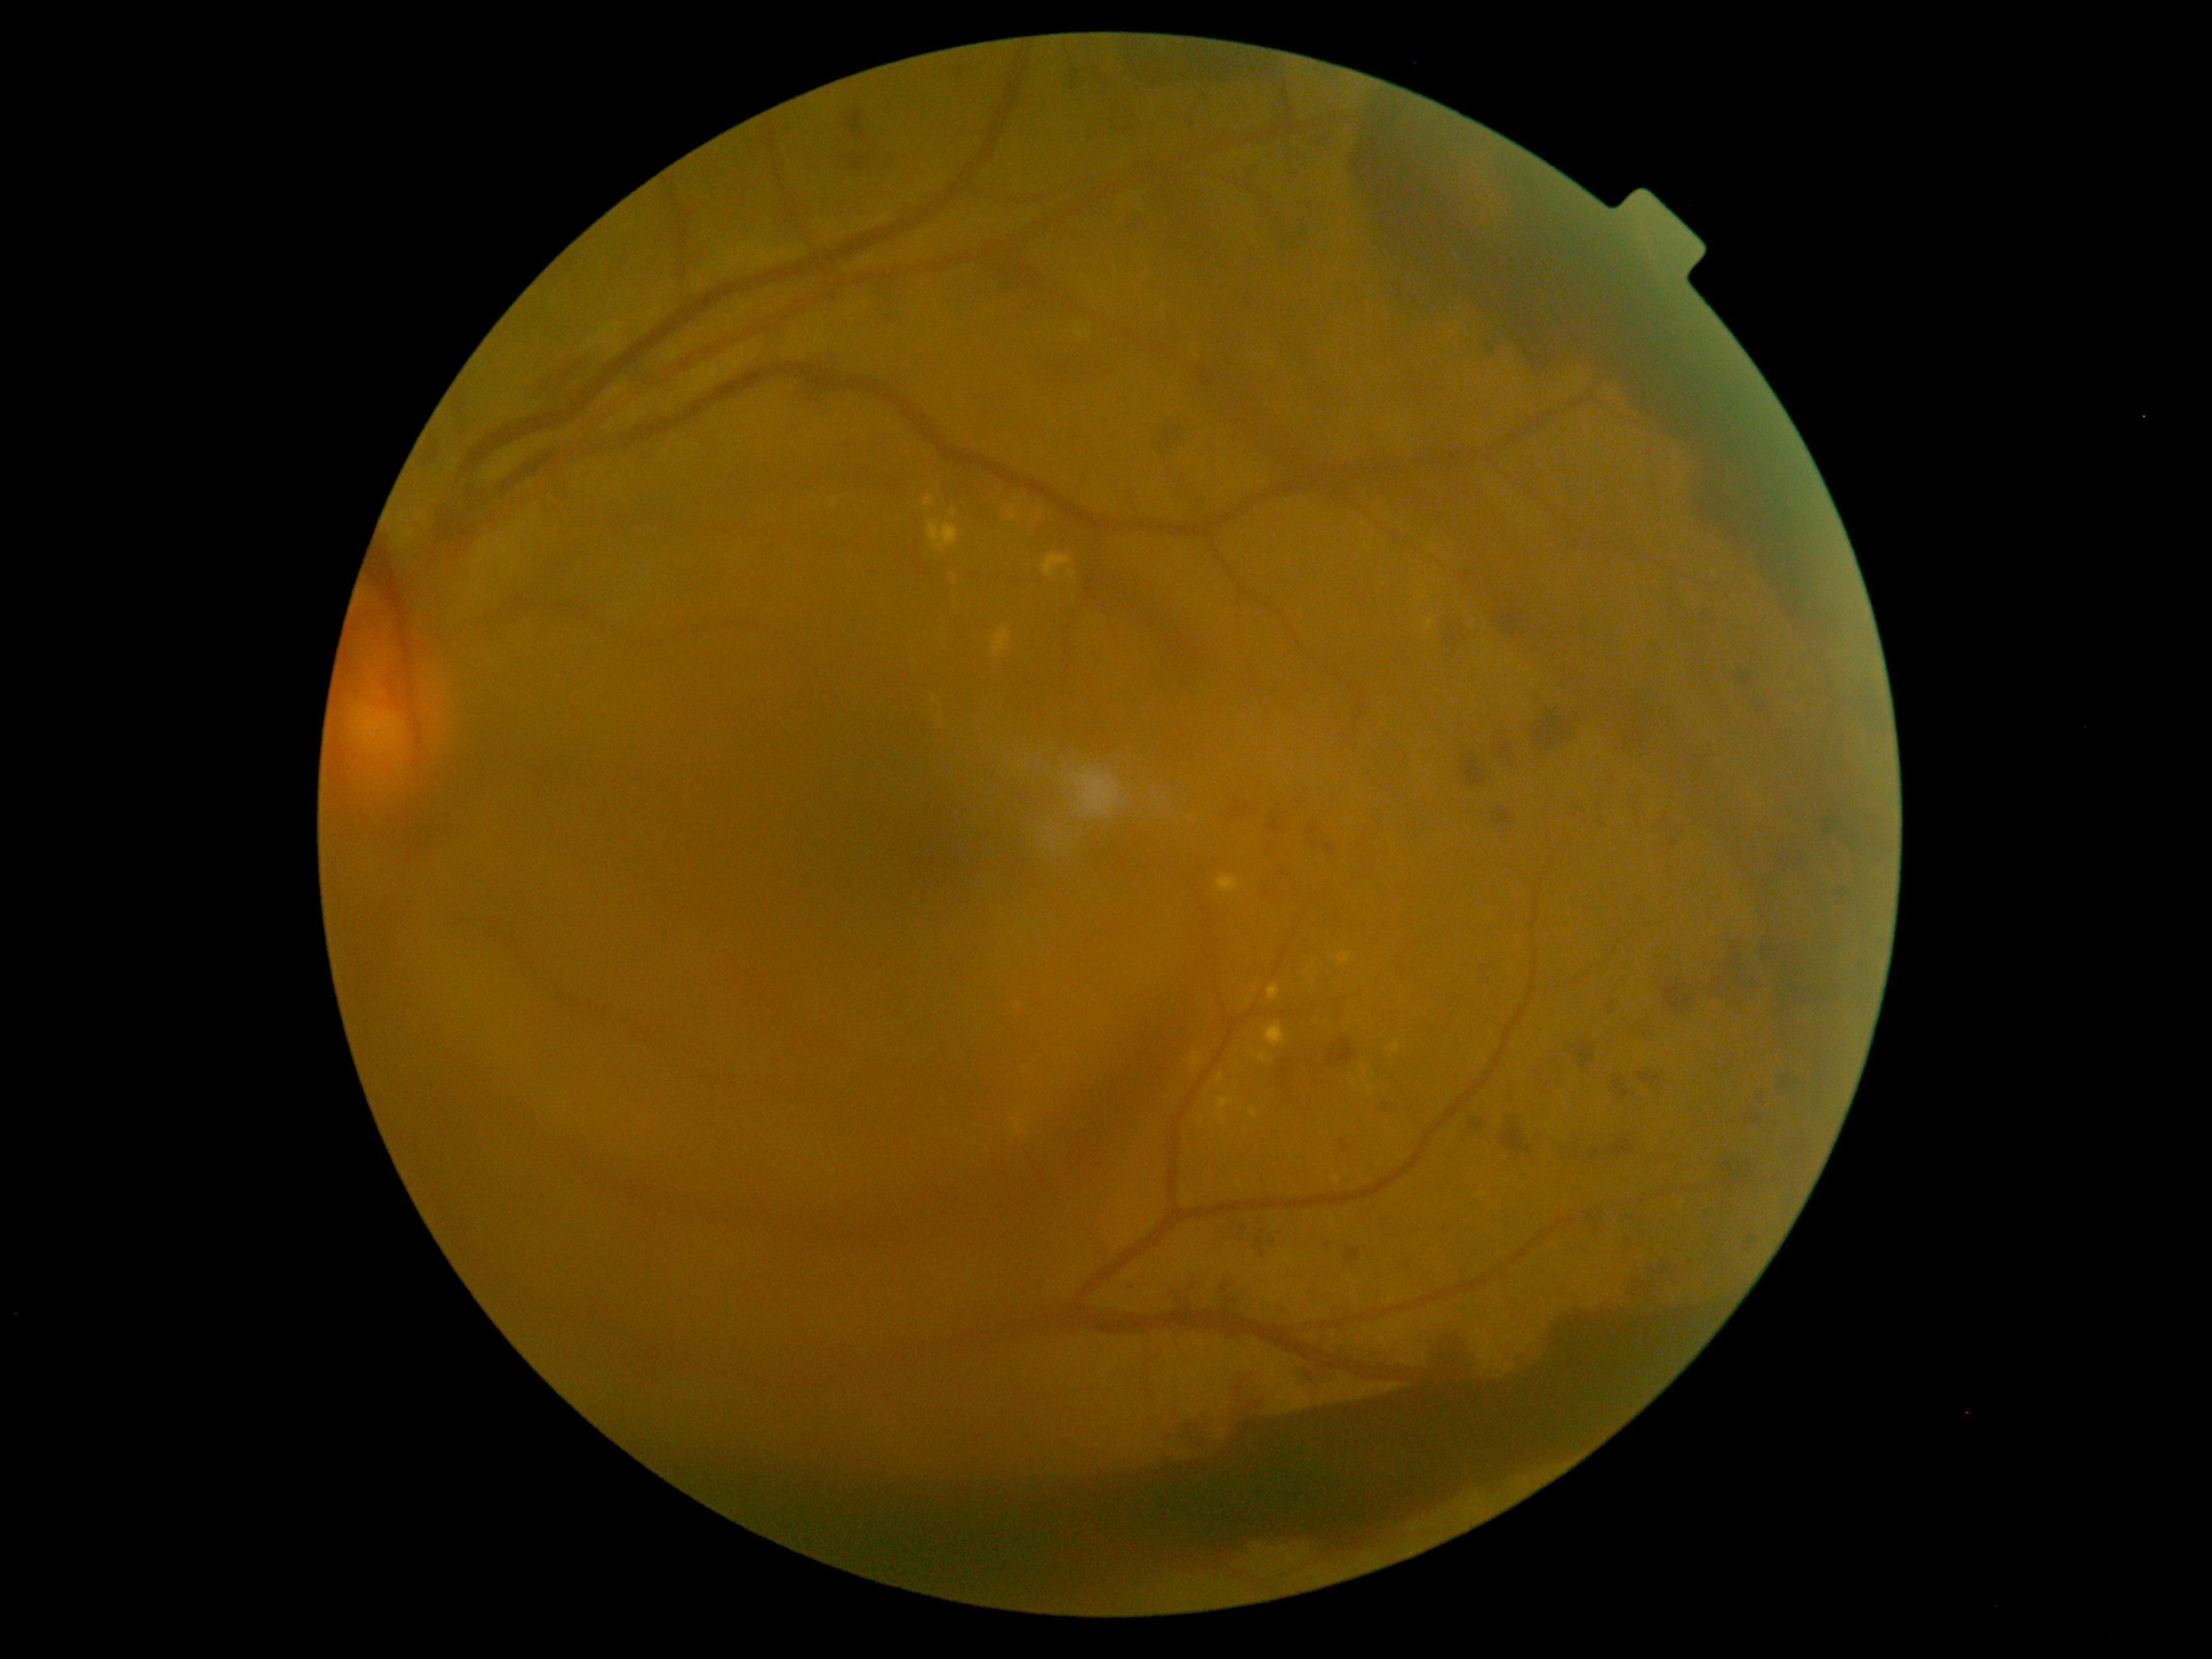
DR stage: PDR (grade 4).
Disease class: proliferative diabetic retinopathy.